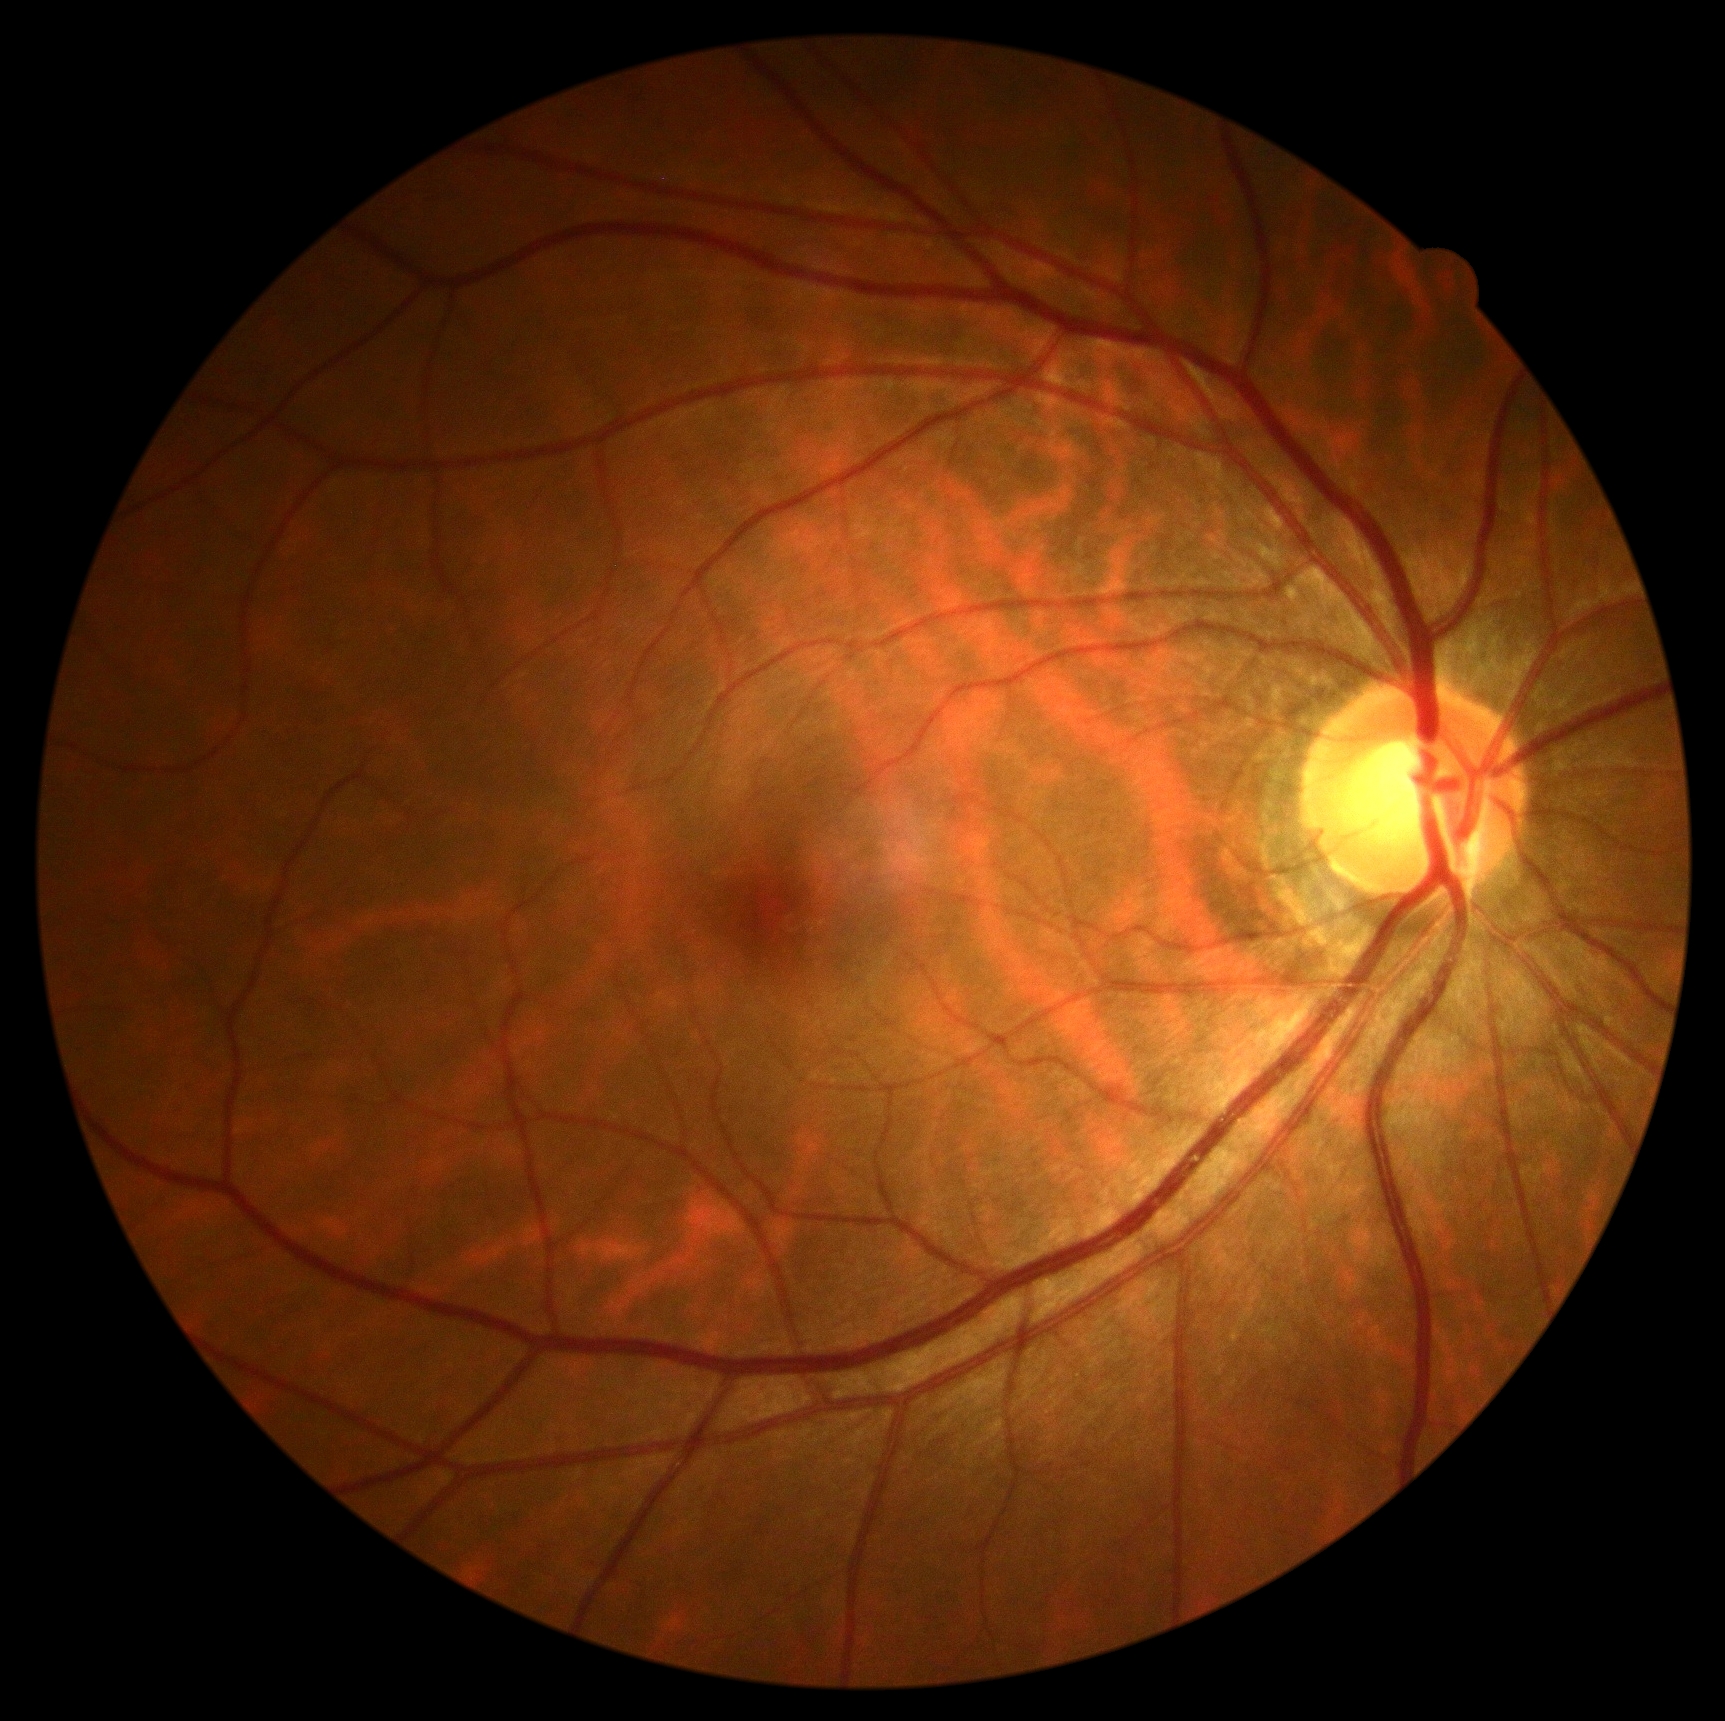 dr_grade: no apparent diabetic retinopathy (grade 0)